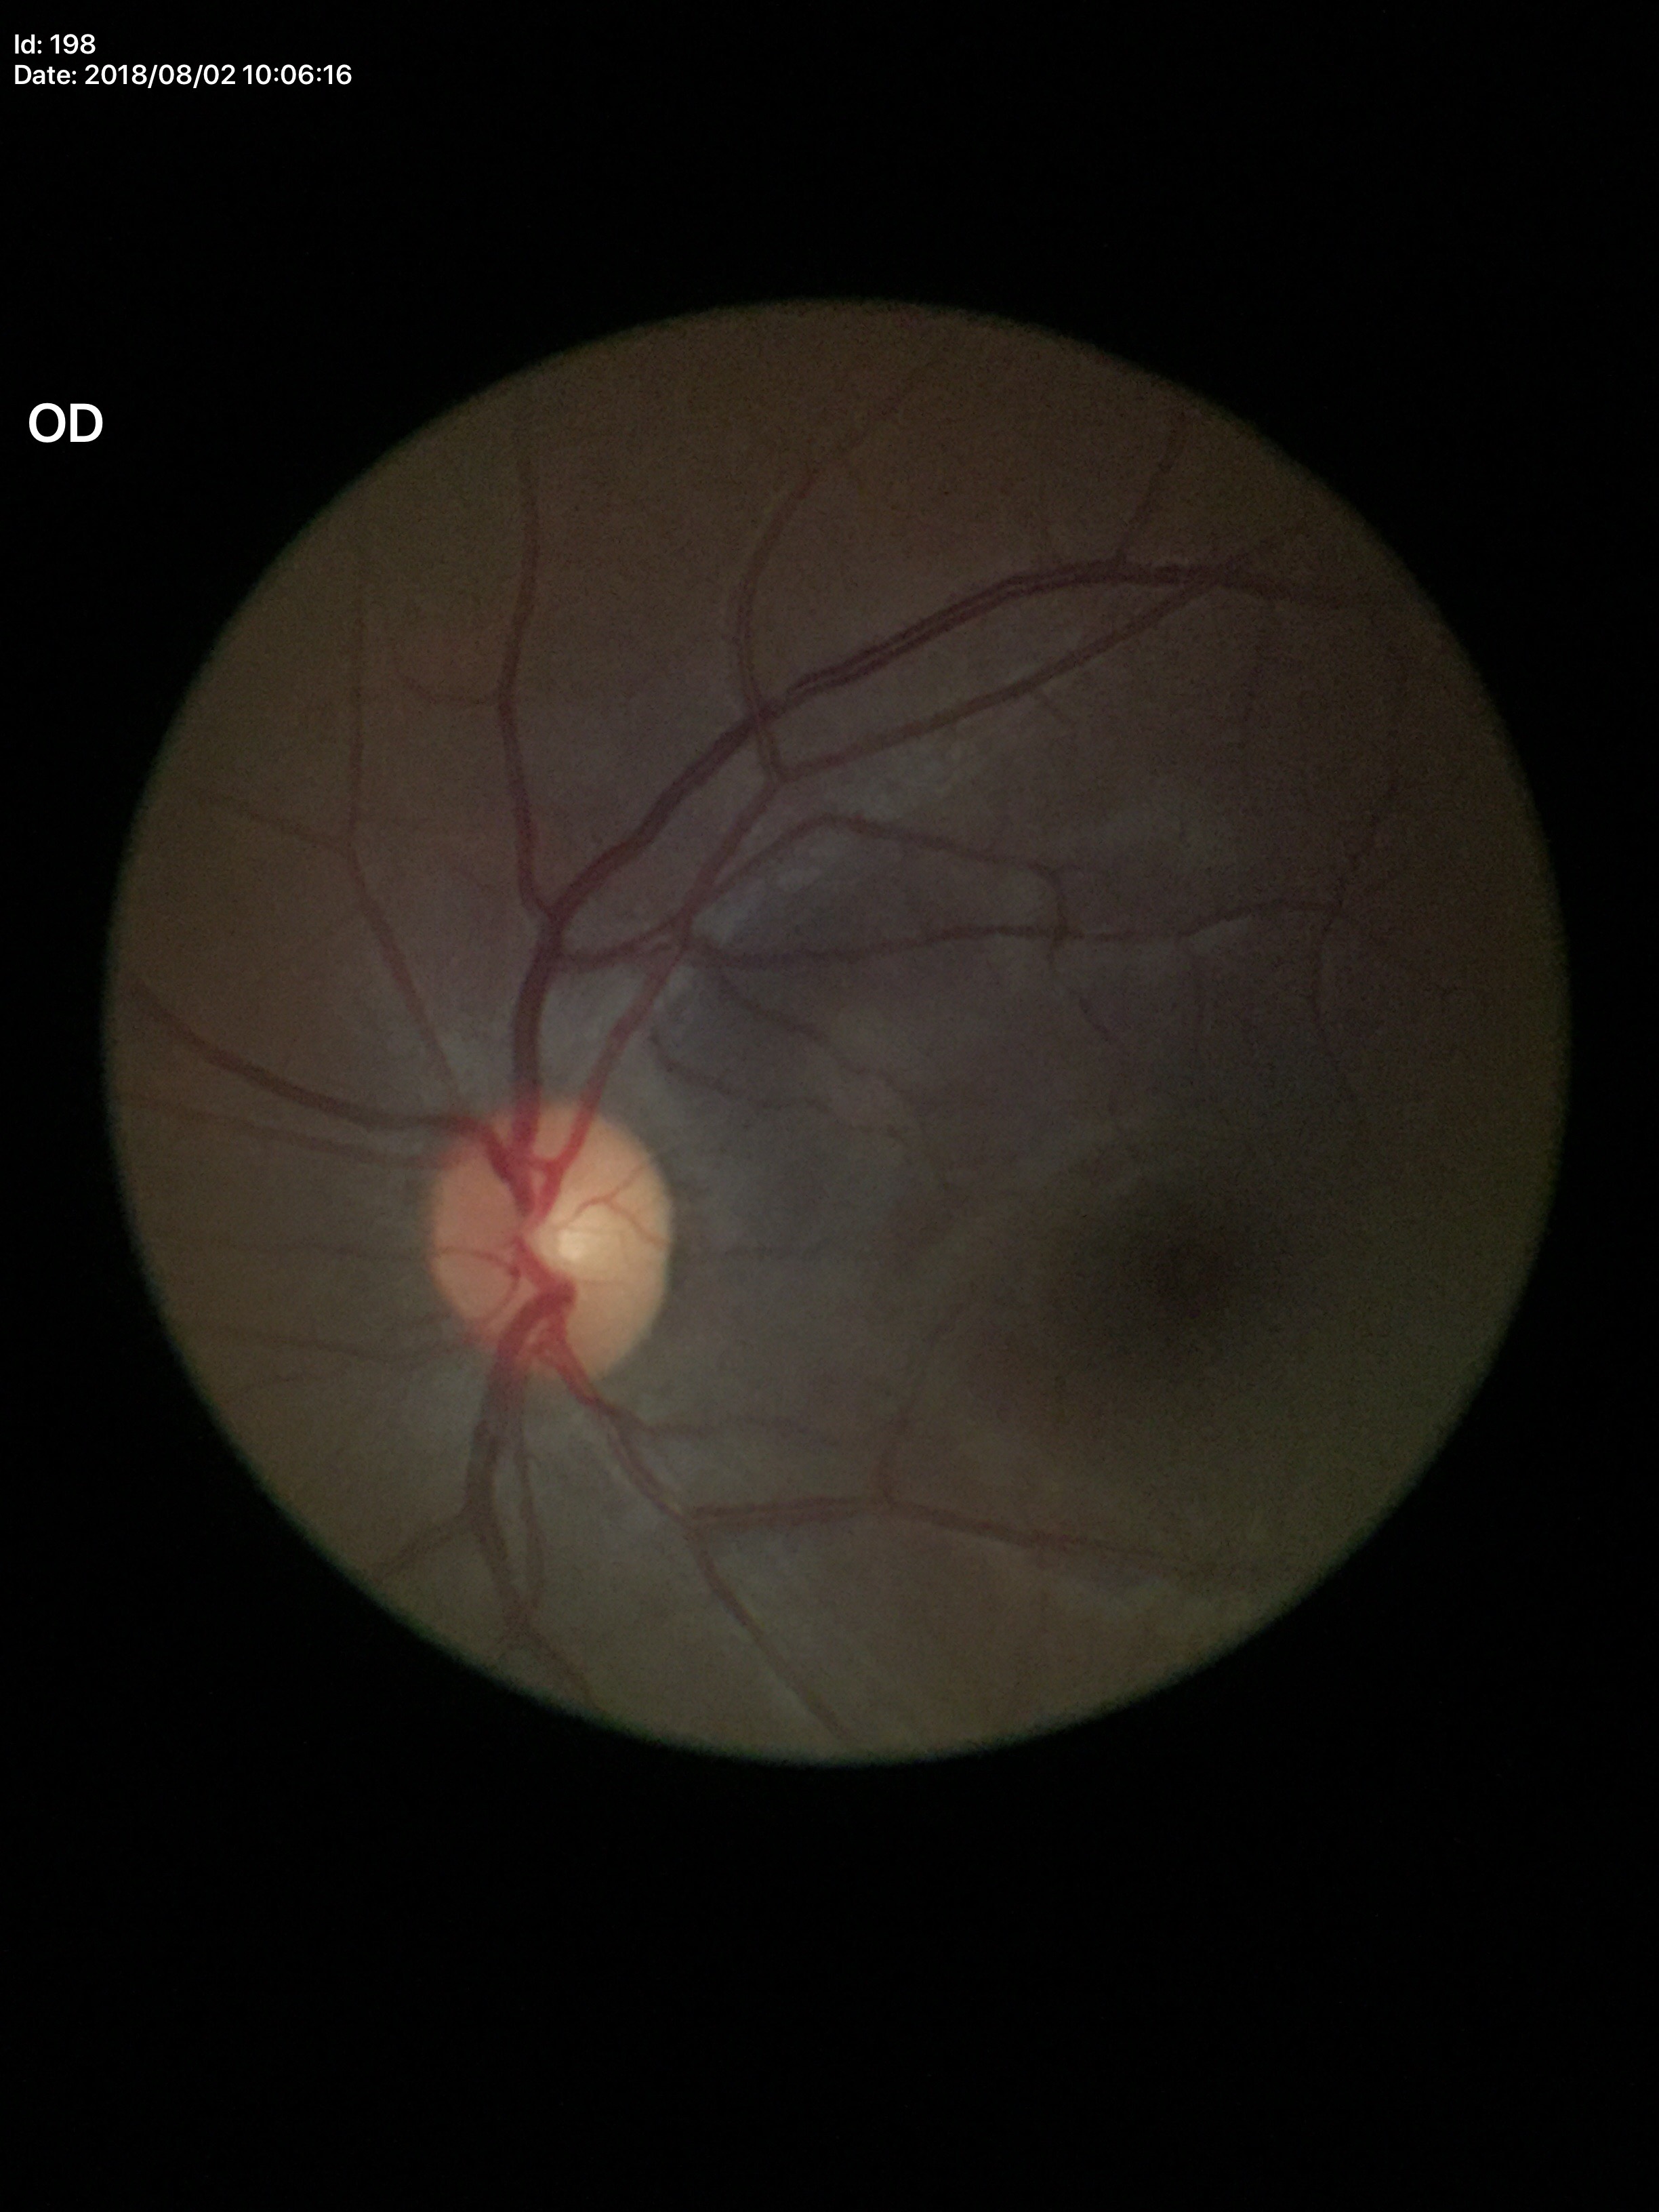
- vertical CDR: 0.46
- Glaucoma impression: negative